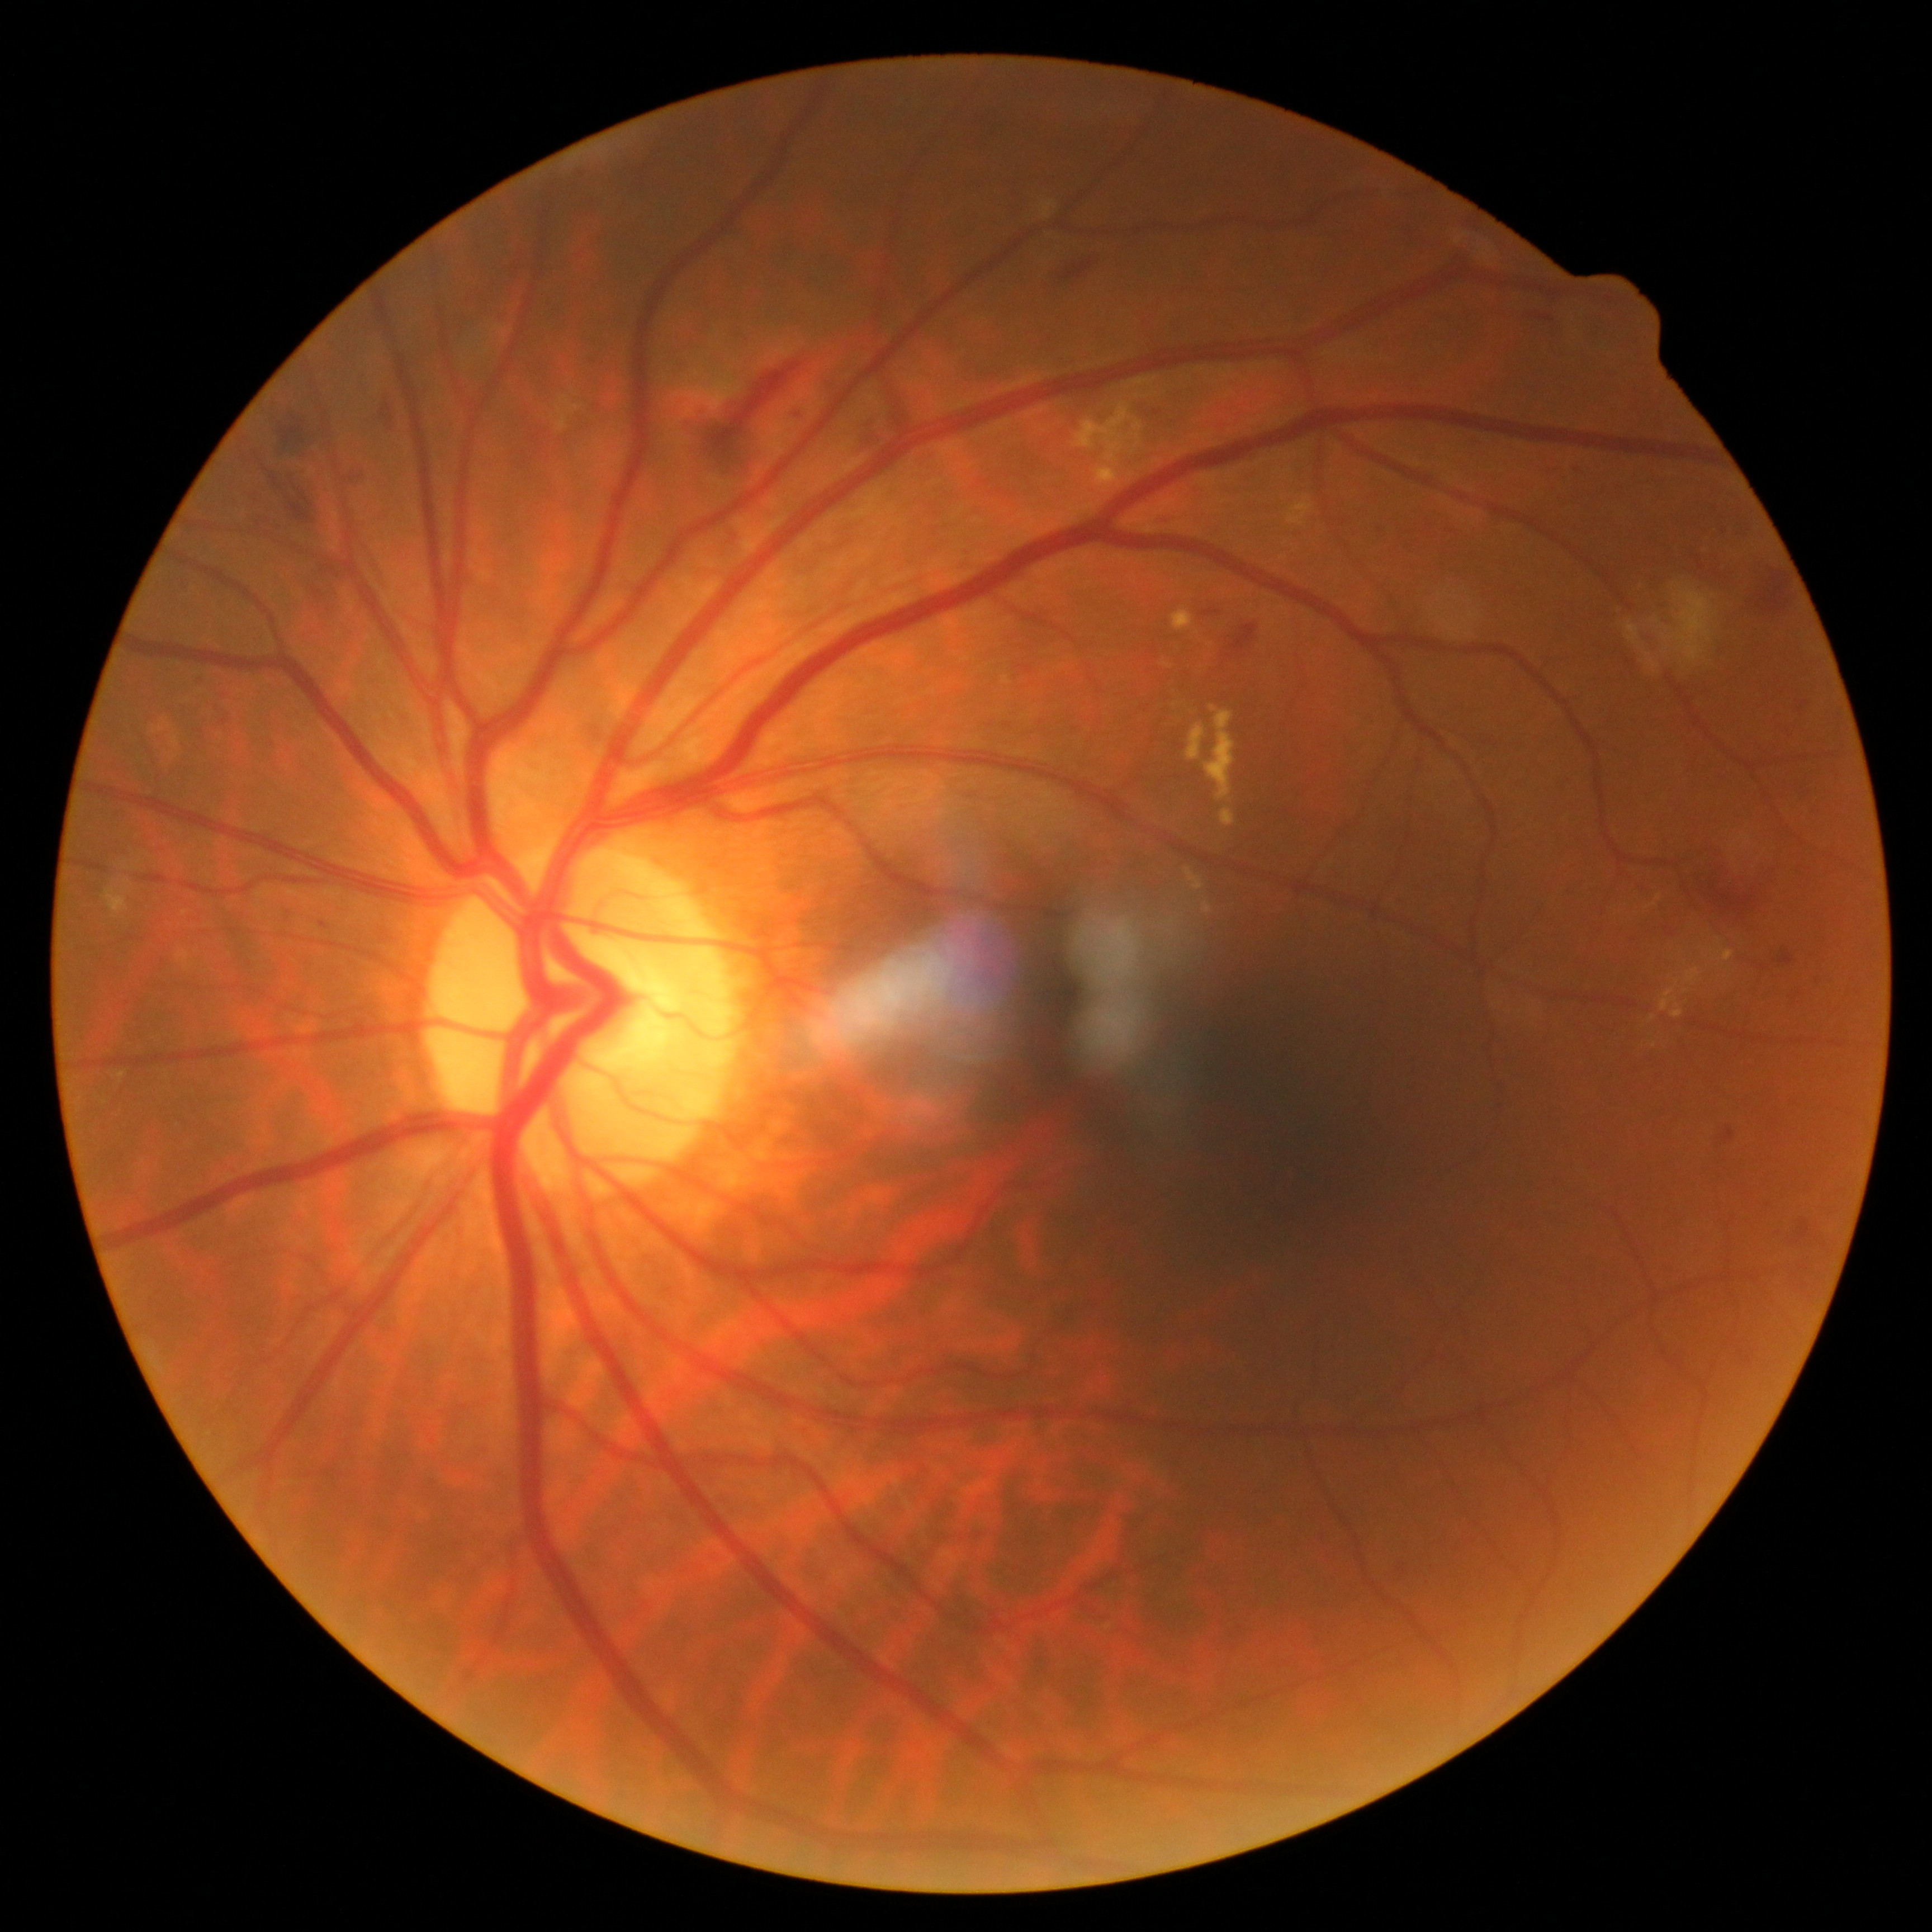
retinopathy grade = 2 (moderate NPDR).